2346x1568. 45-degree field of view
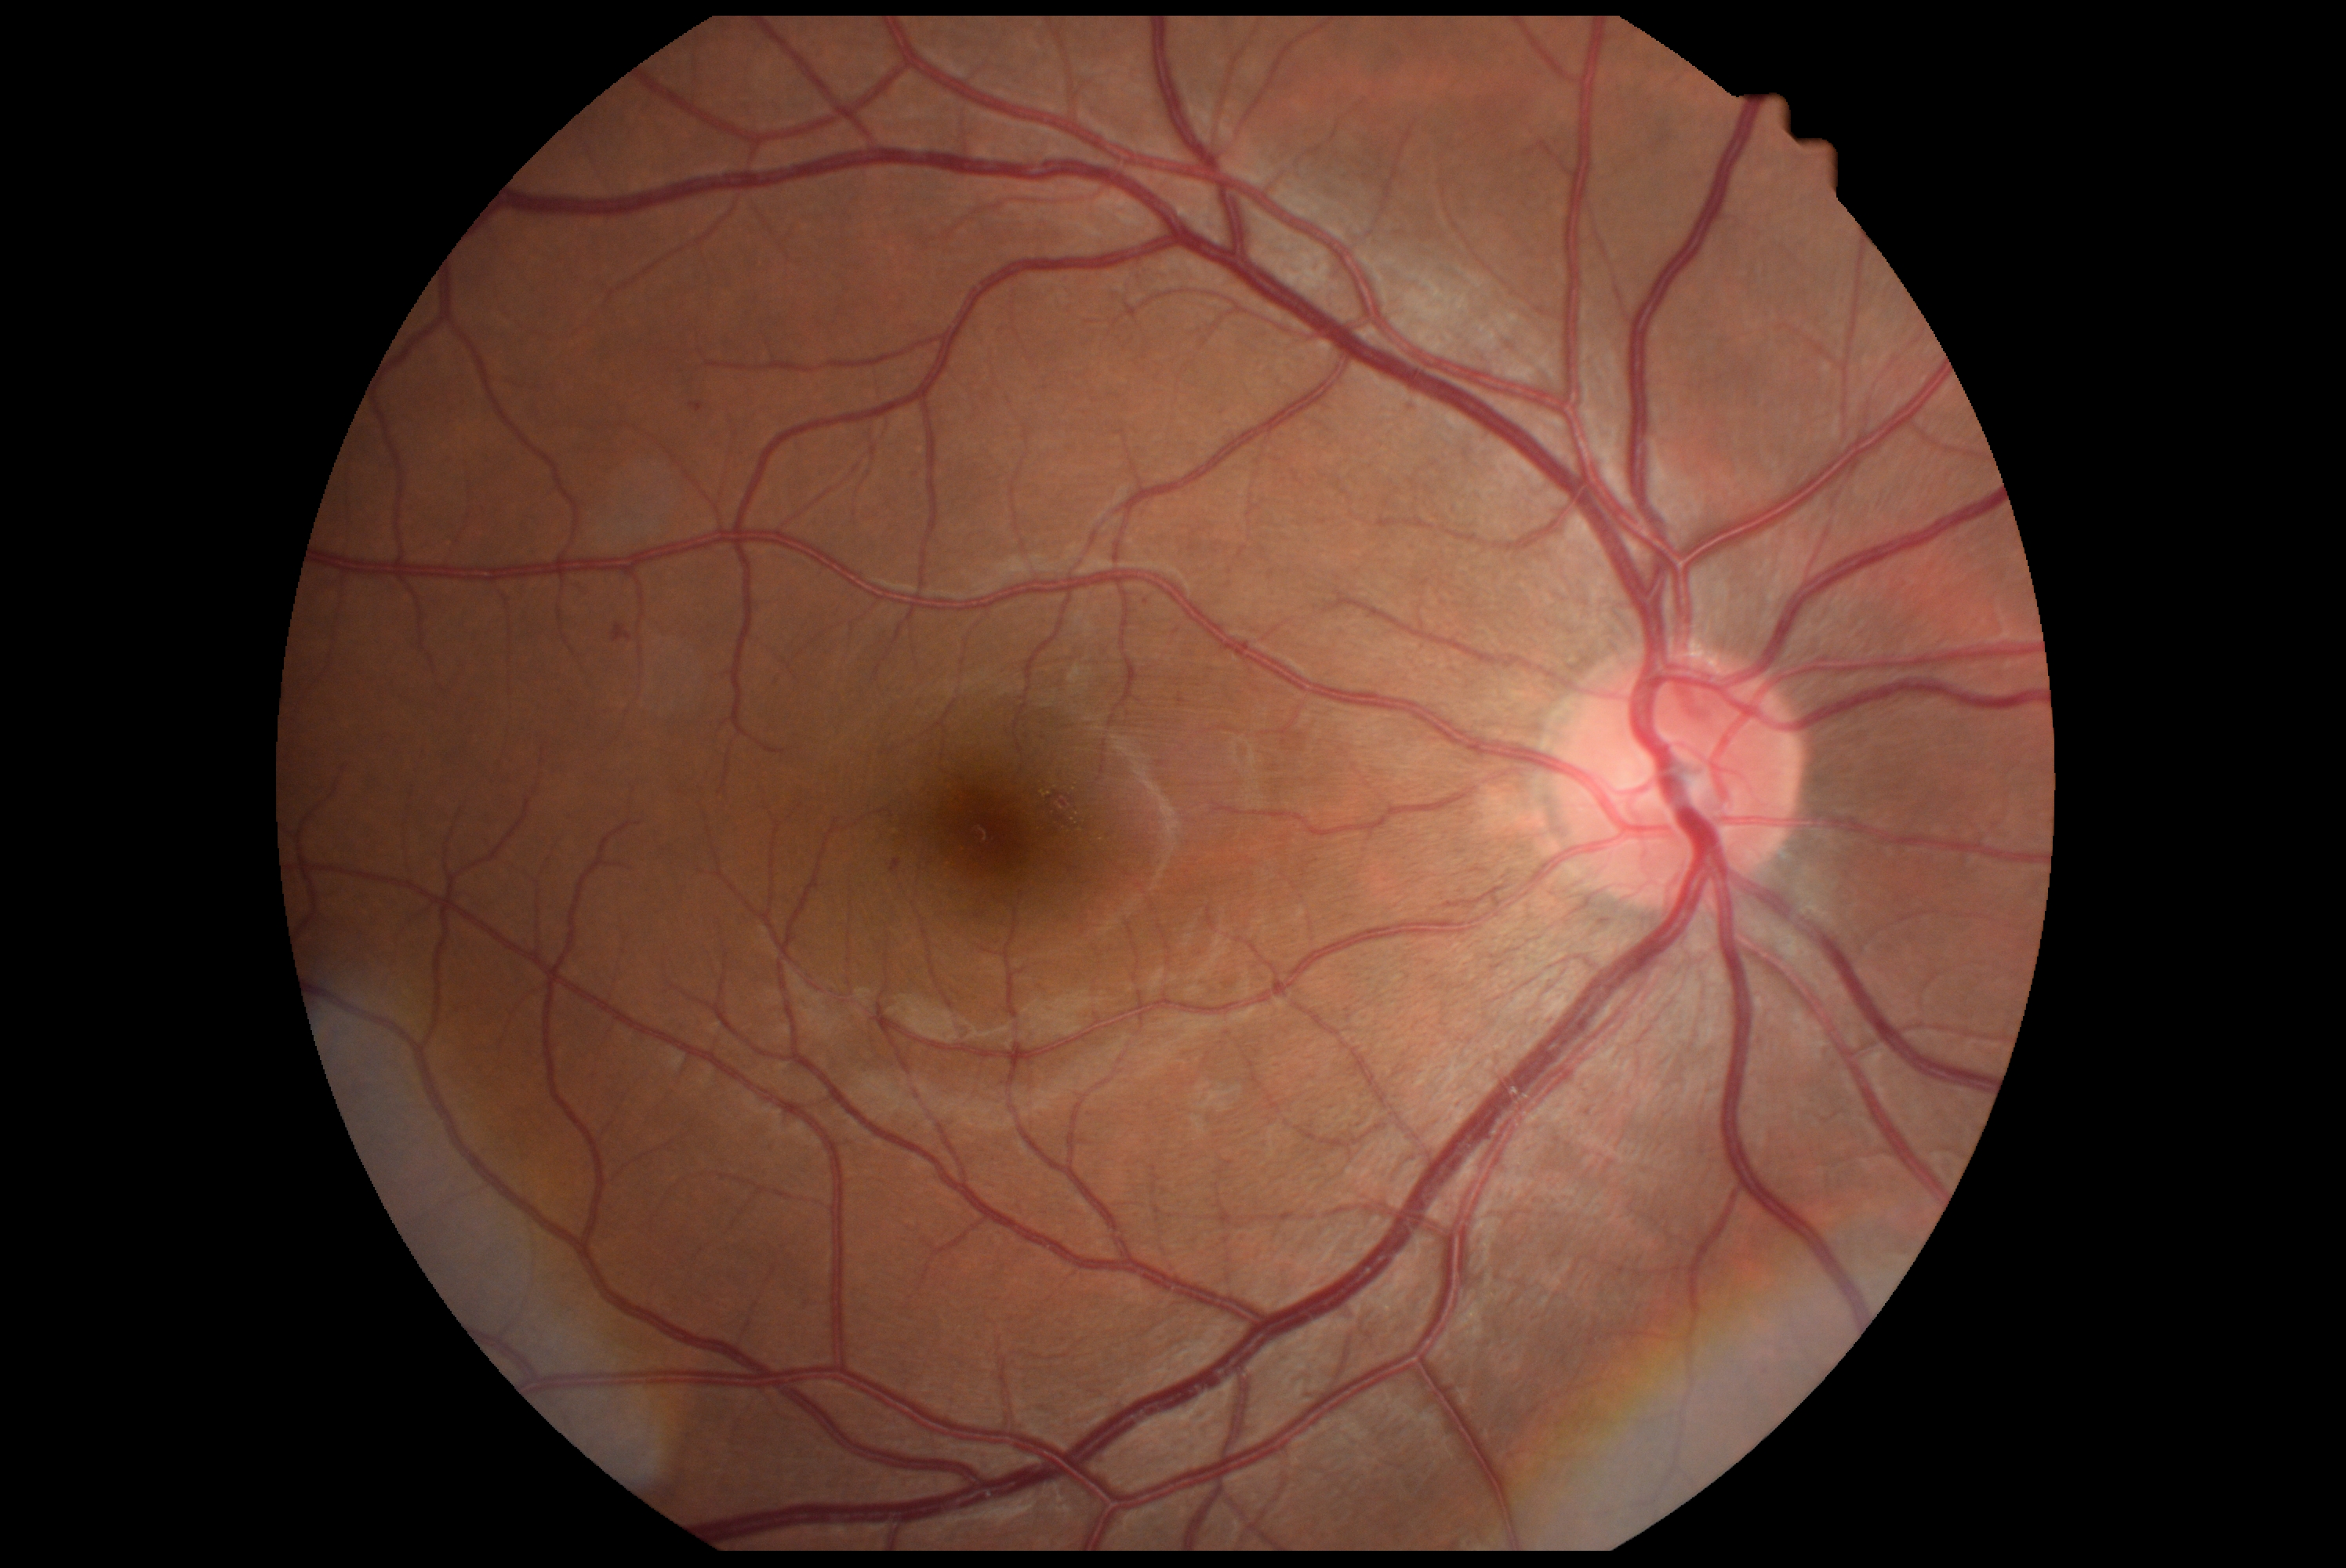 dr_grade: 2